45° FOV, retinal fundus photograph, image size 1536x1152: 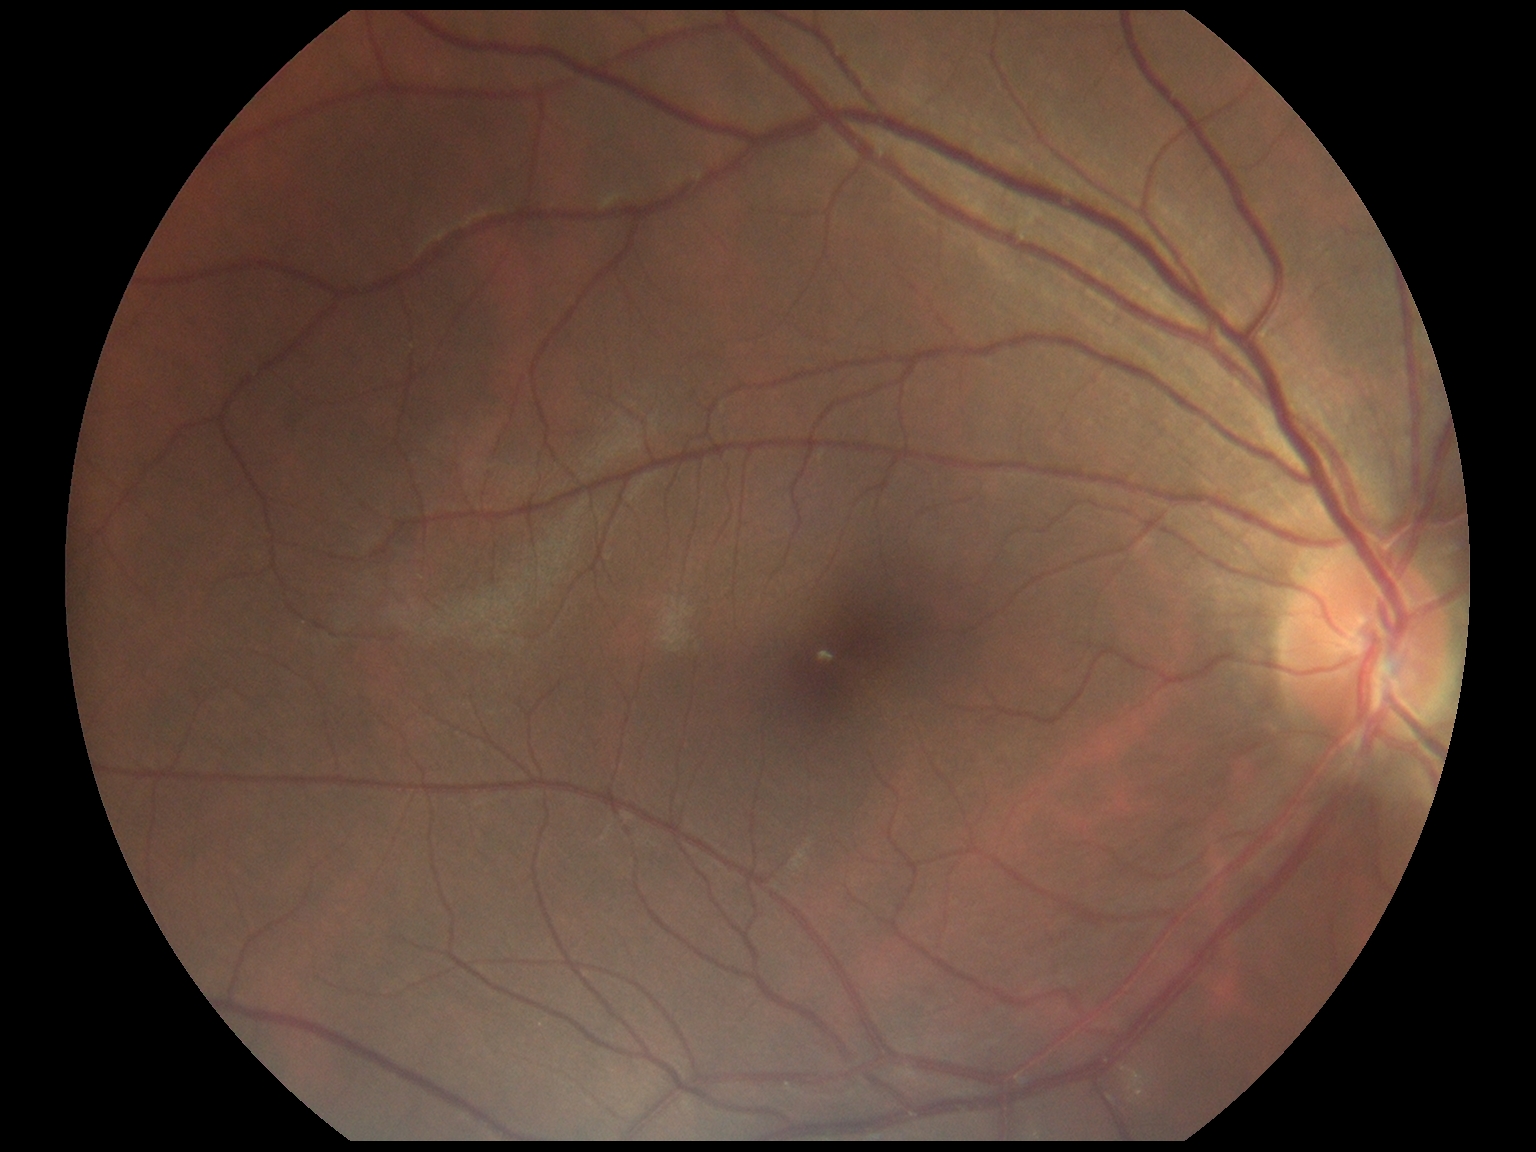 DR severity: no apparent retinopathy (grade 0).
No diabetic retinal disease findings.